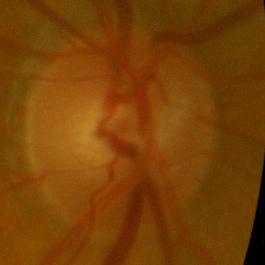 No glaucomatous changes.